Wide-field fundus photograph of an infant · 1240 x 1240 pixels:
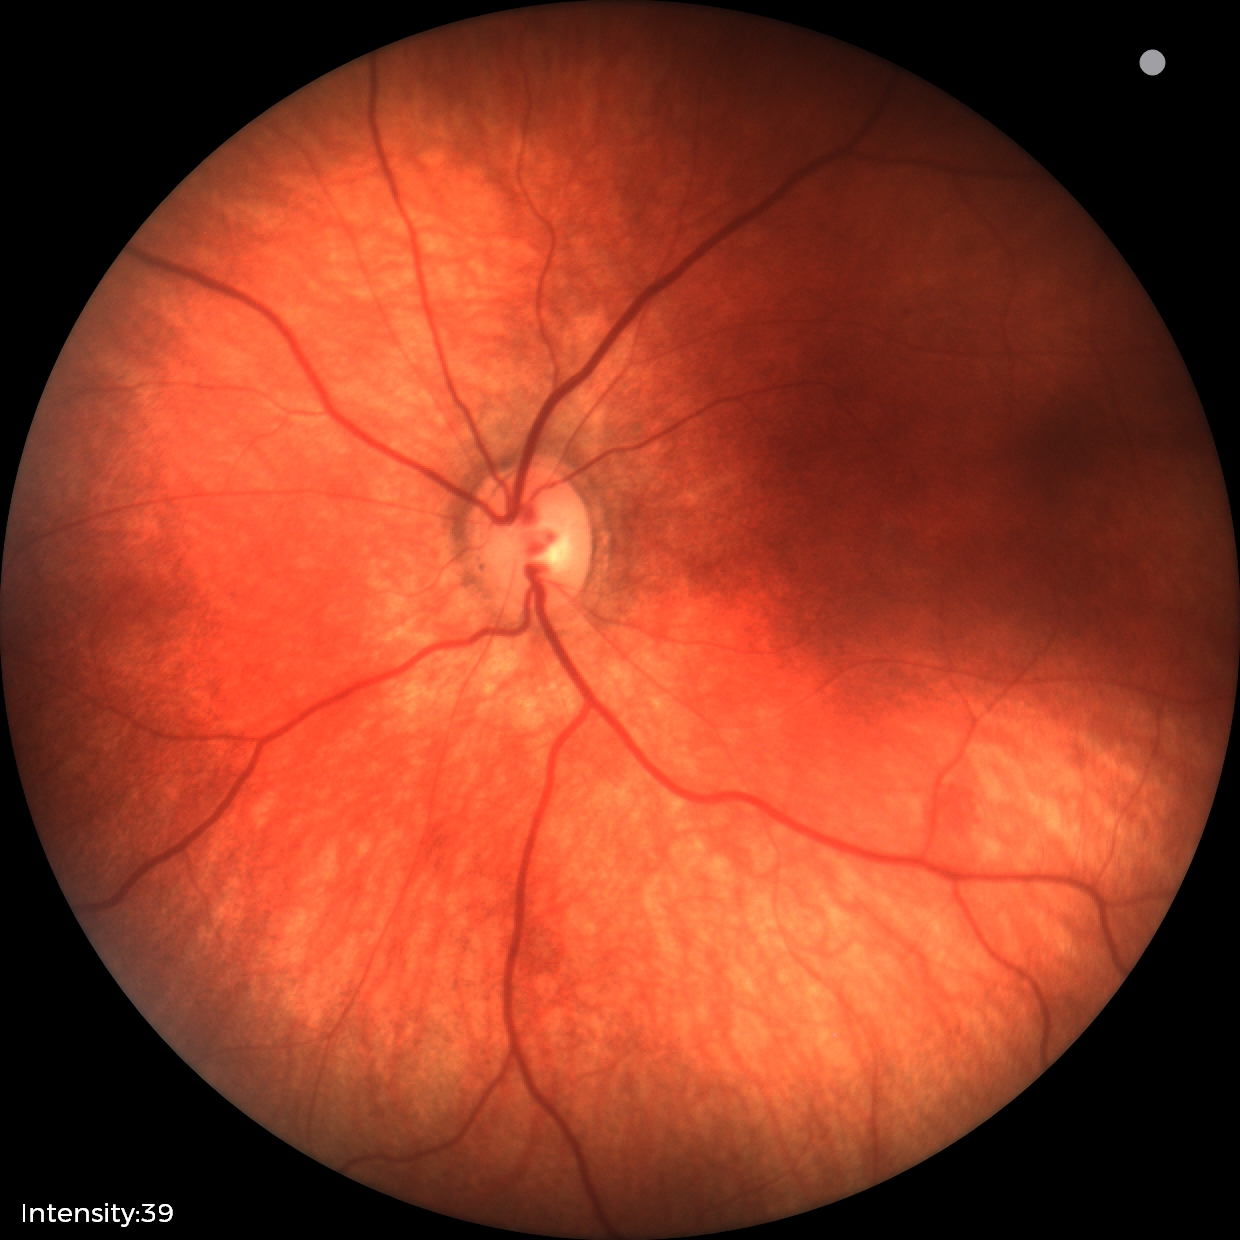
Finding = retinal hemorrhages